45° FOV:
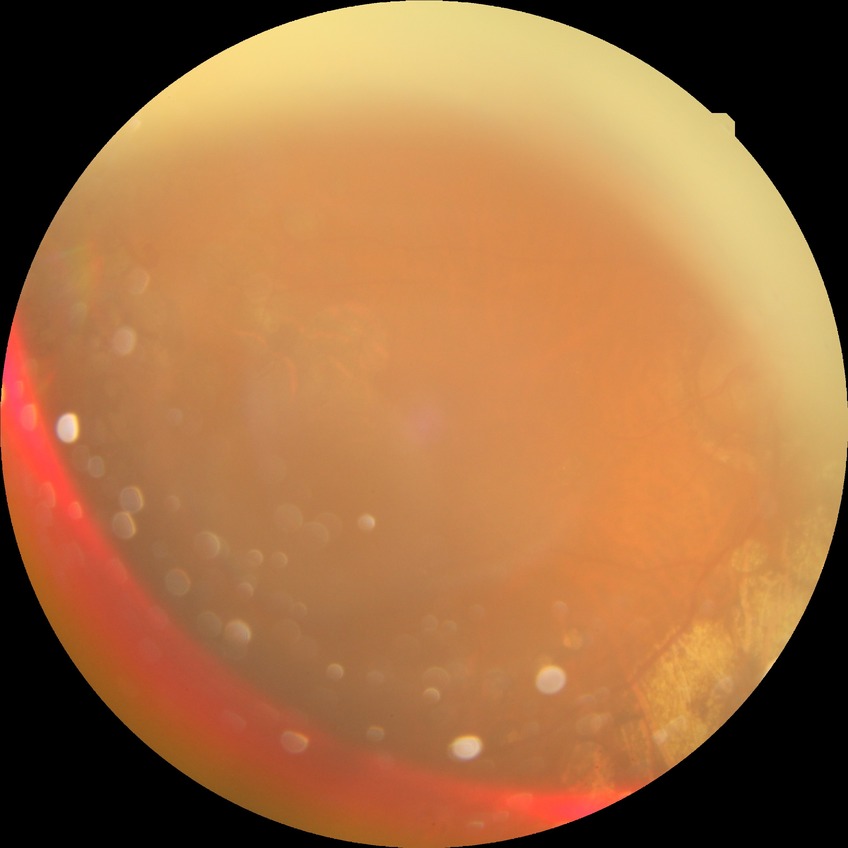

DR severity is PDR.